Diabetic retinopathy graded by the modified Davis classification:
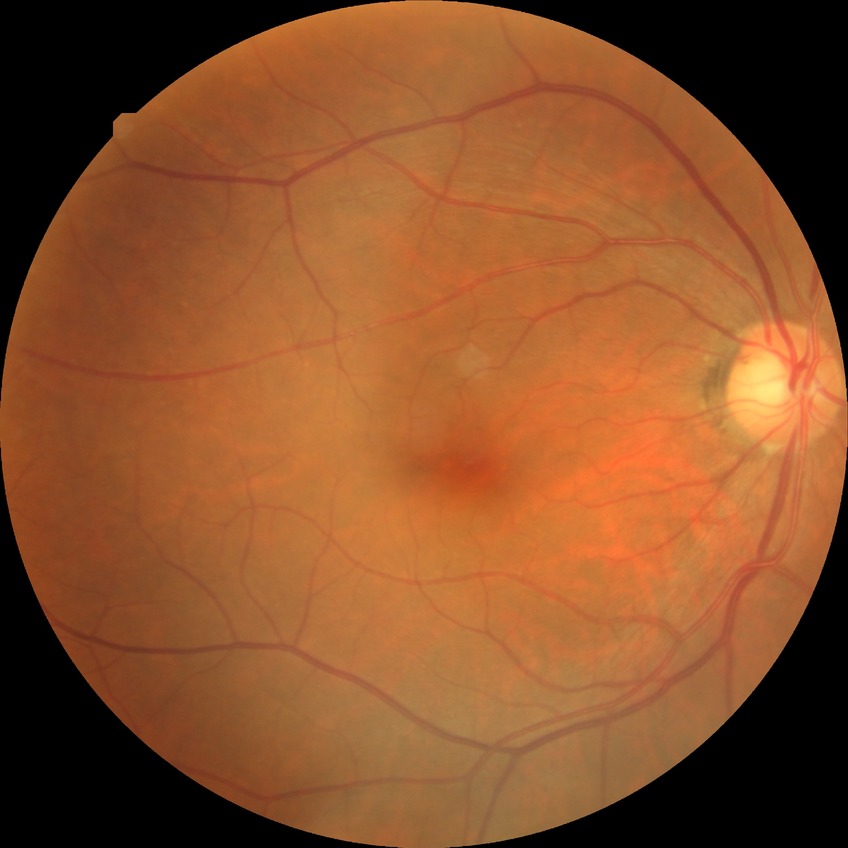
davis_grade: simple diabetic retinopathy (SDR)